2361x1568 · CFP · 50° field of view
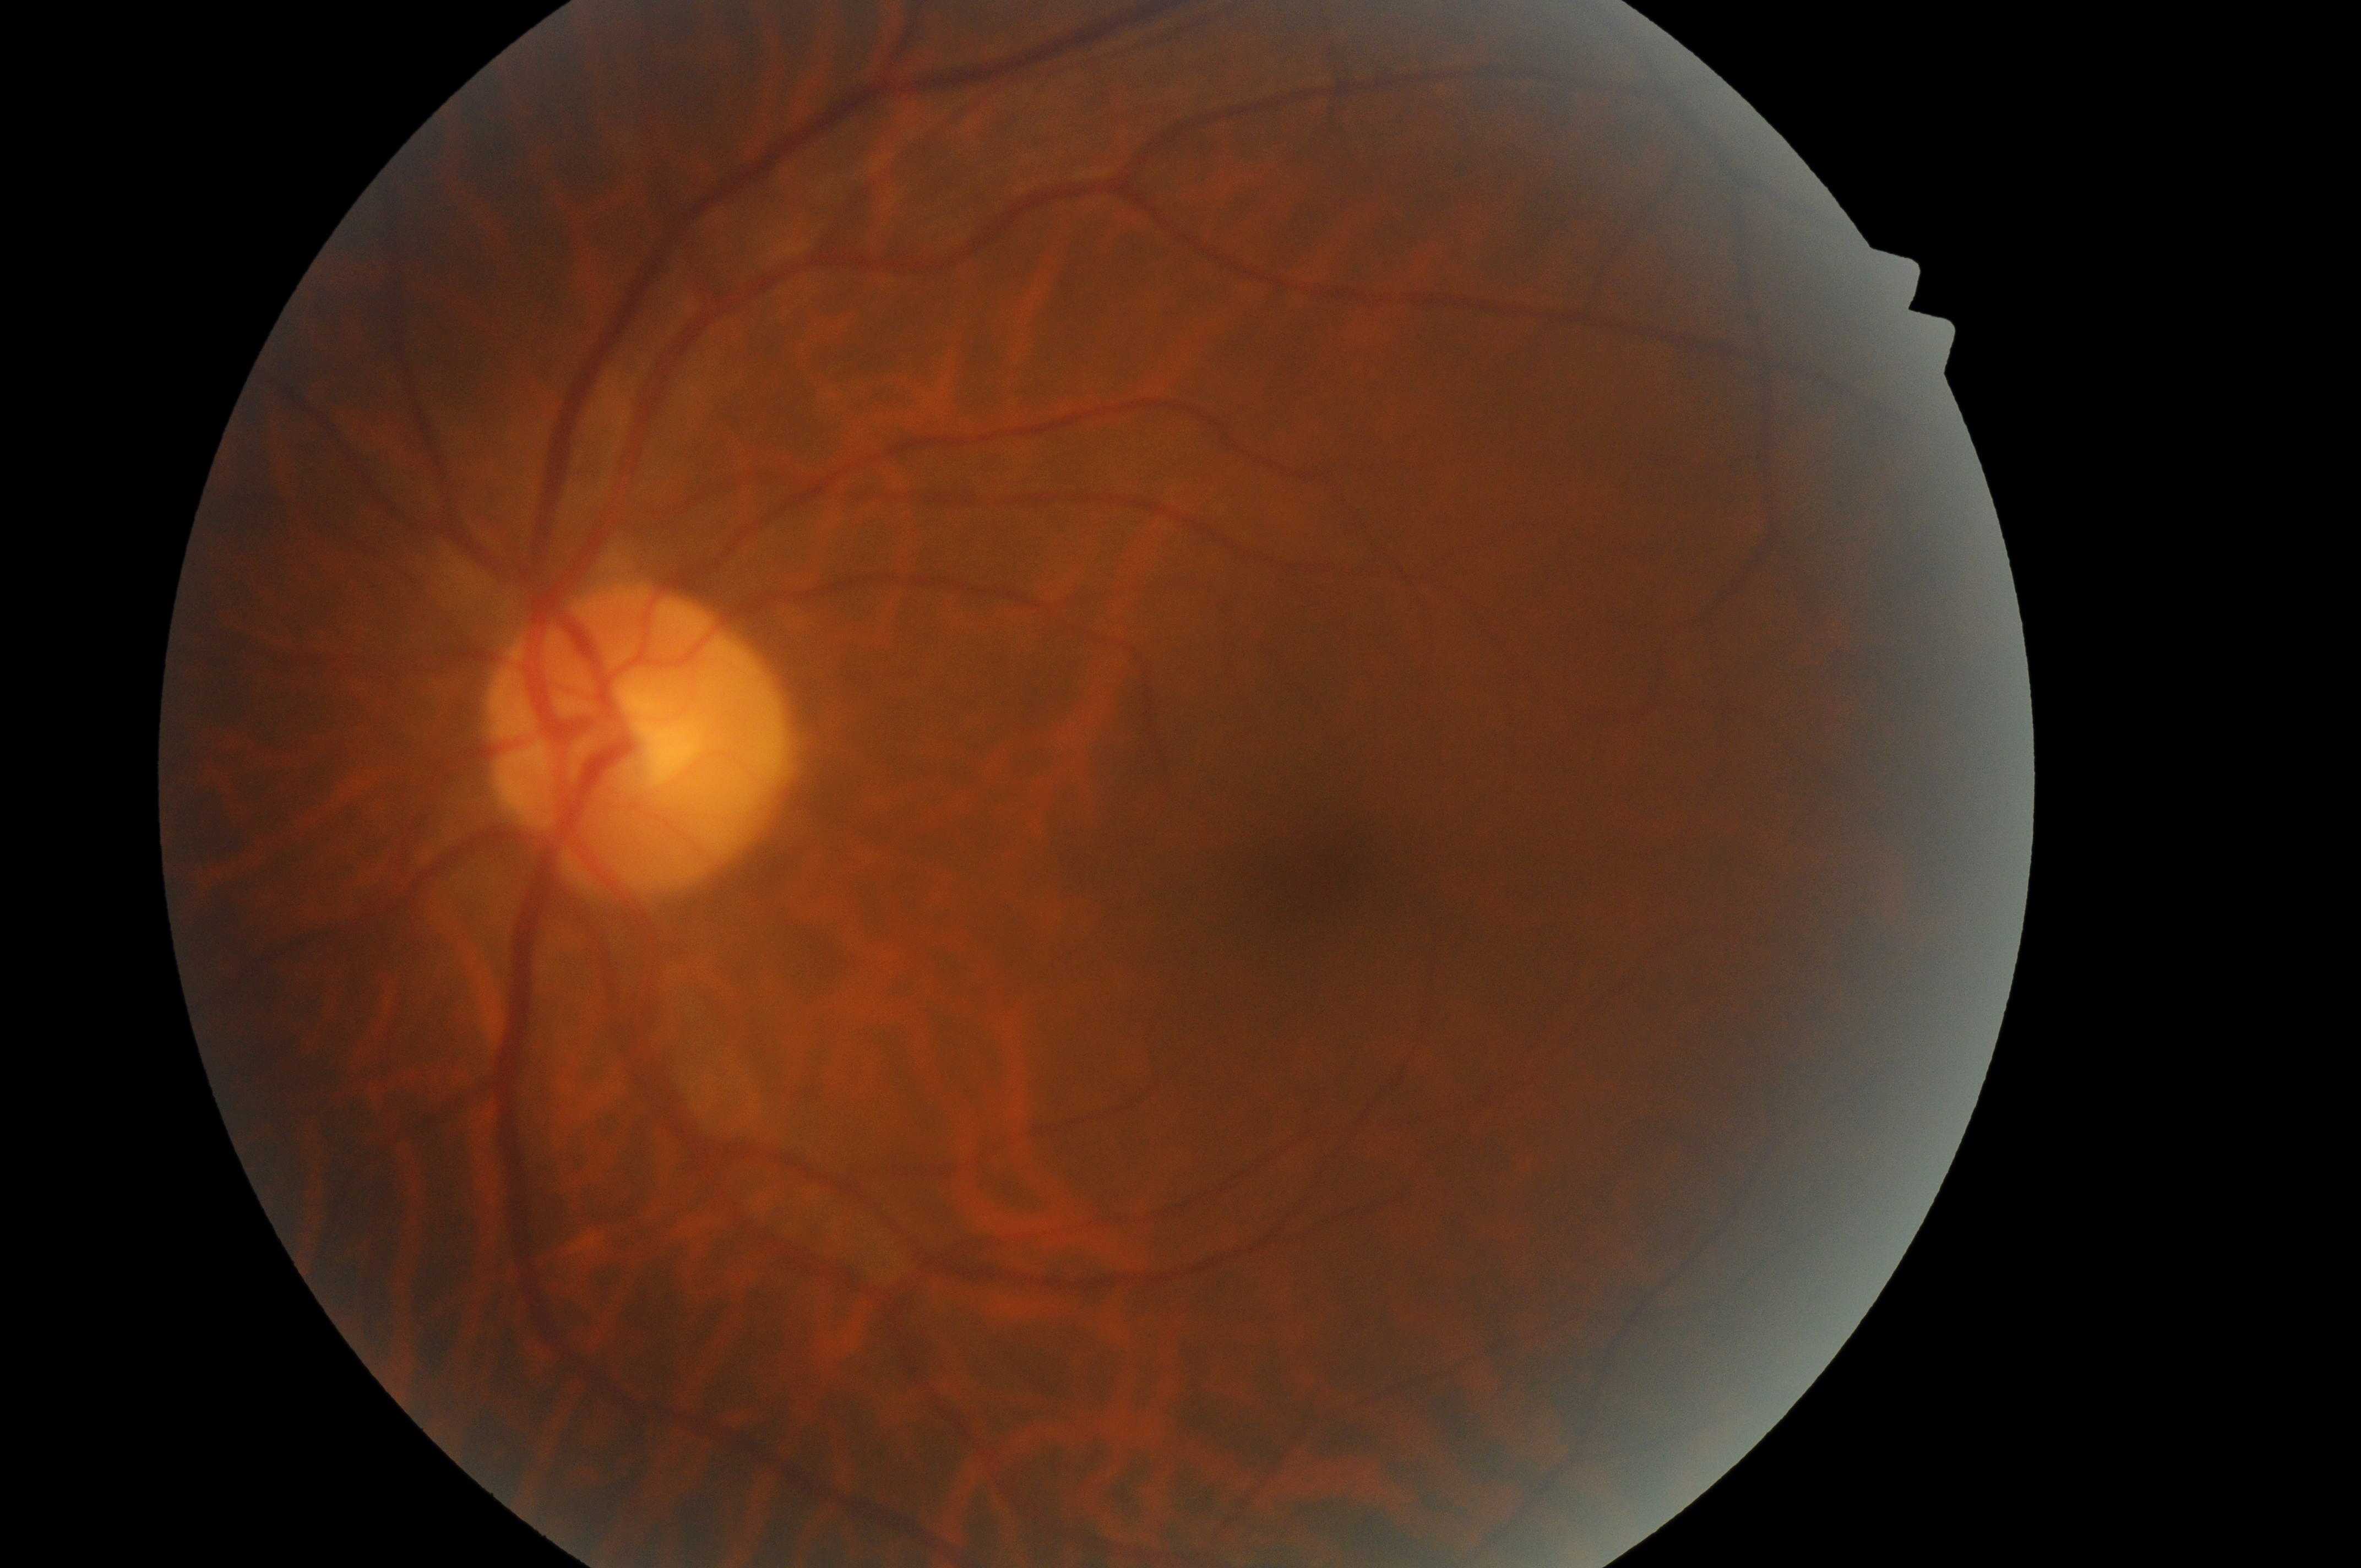

disc center=(639, 754); foveal center=(1336, 884); oculus sinister; risk of diabetic macular edema=grade 0; diabetic retinopathy=grade 0.